Graded on the modified Davis scale.
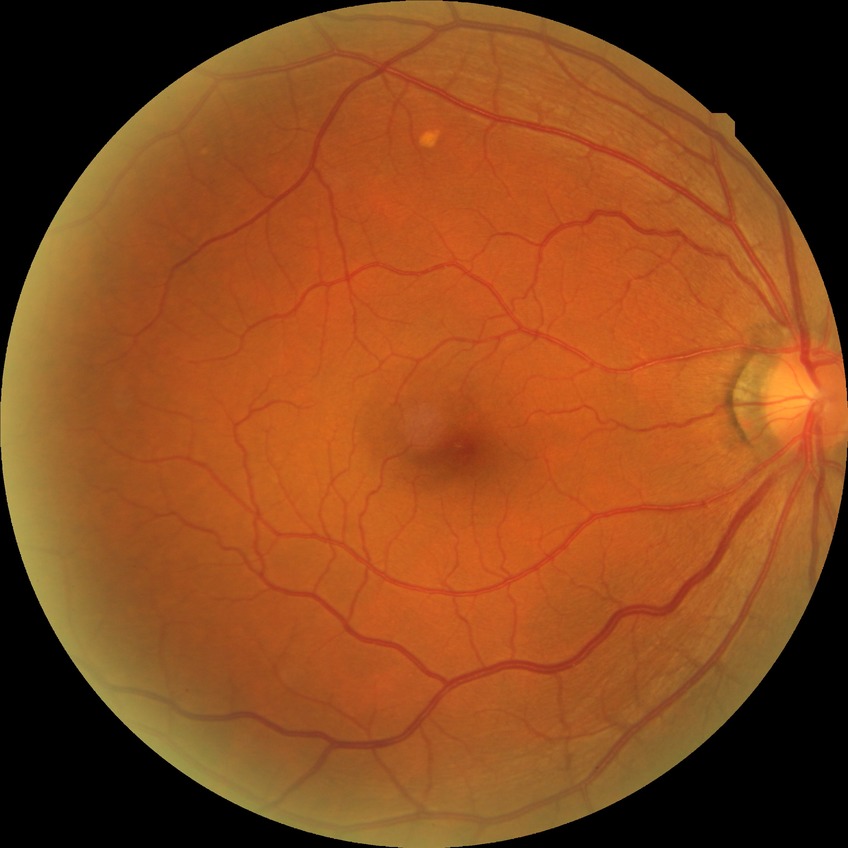
{"davis_grade": "no diabetic retinopathy"}